Diabetic retinopathy graded by the modified Davis classification
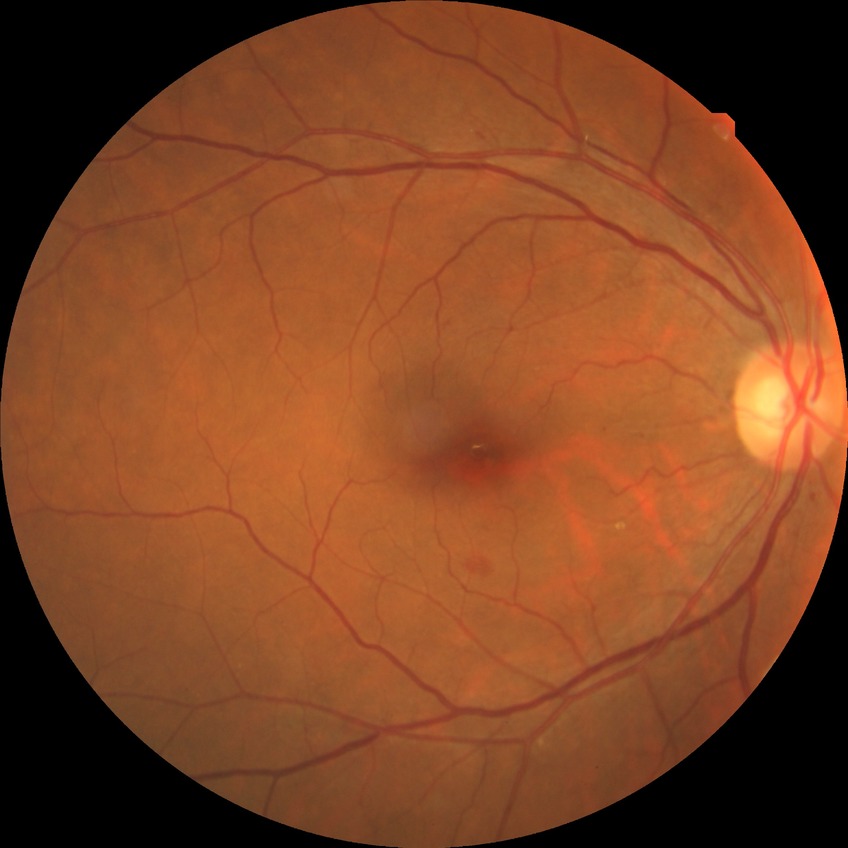
Diabetic retinopathy (DR) is simple diabetic retinopathy (SDR).